Macula-centered field. 1932x1932px — 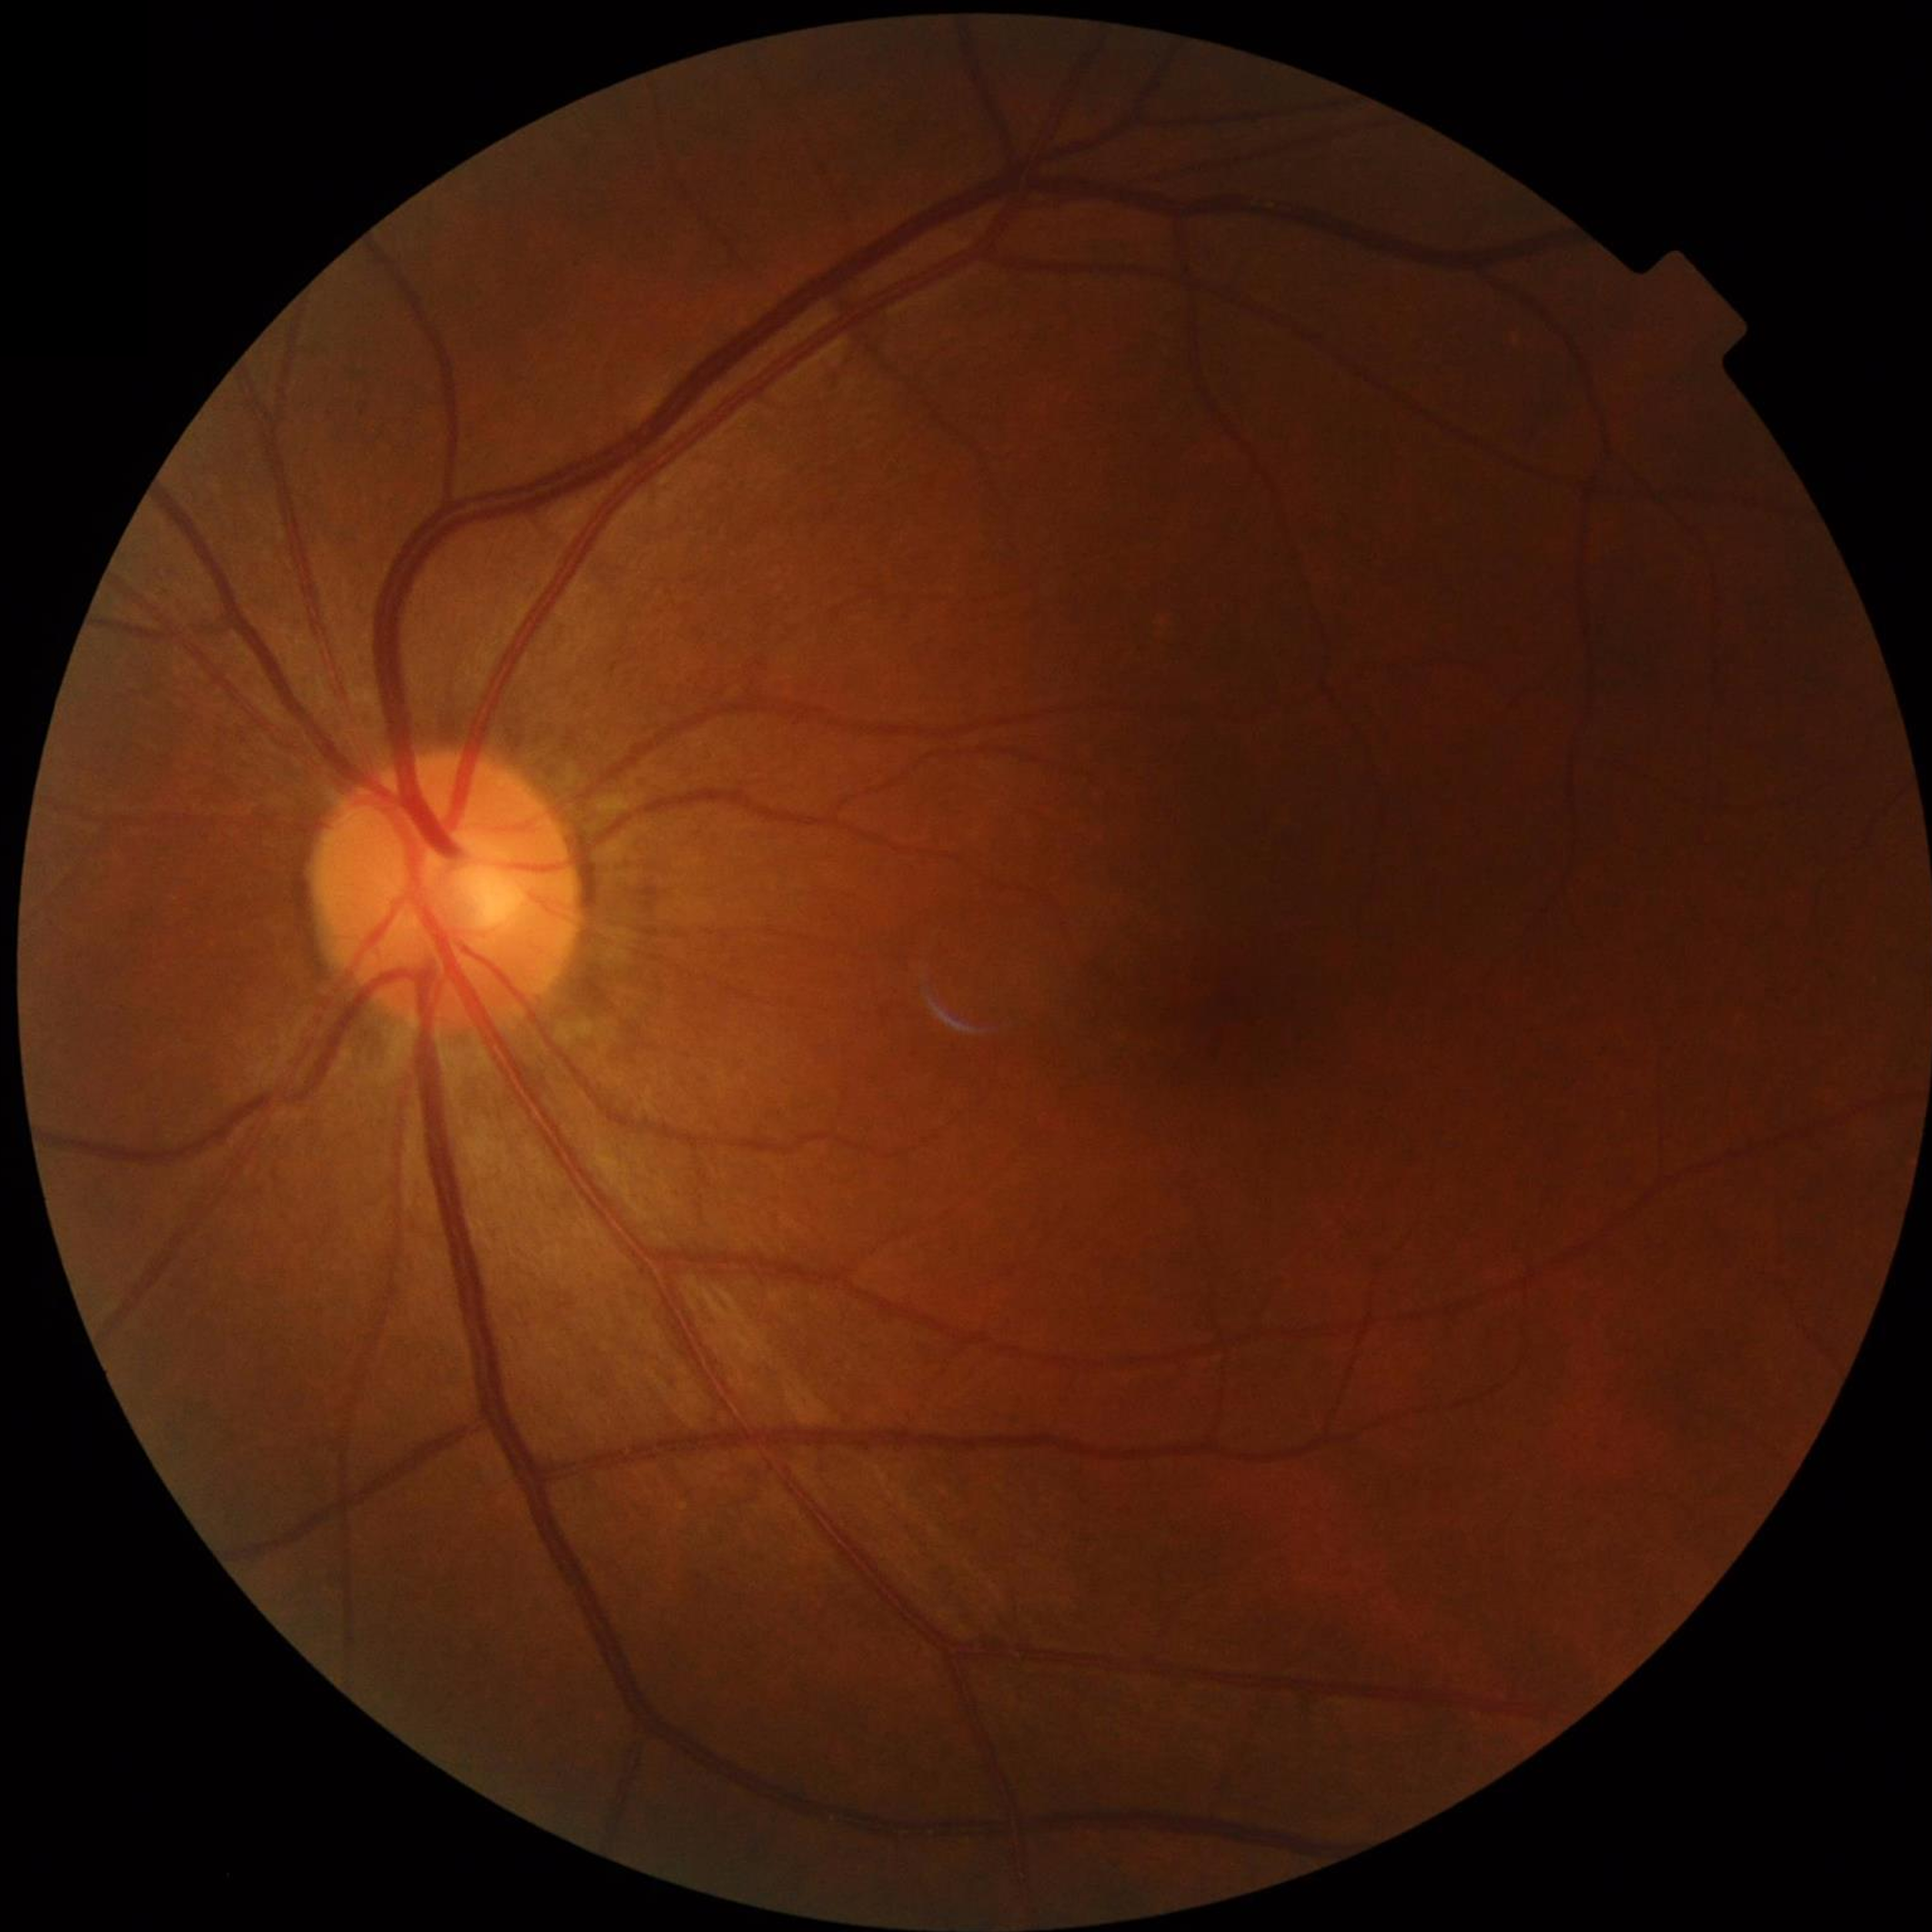 Automated quality assessment: adequate. No AMD, DR, or glaucomatous findings.